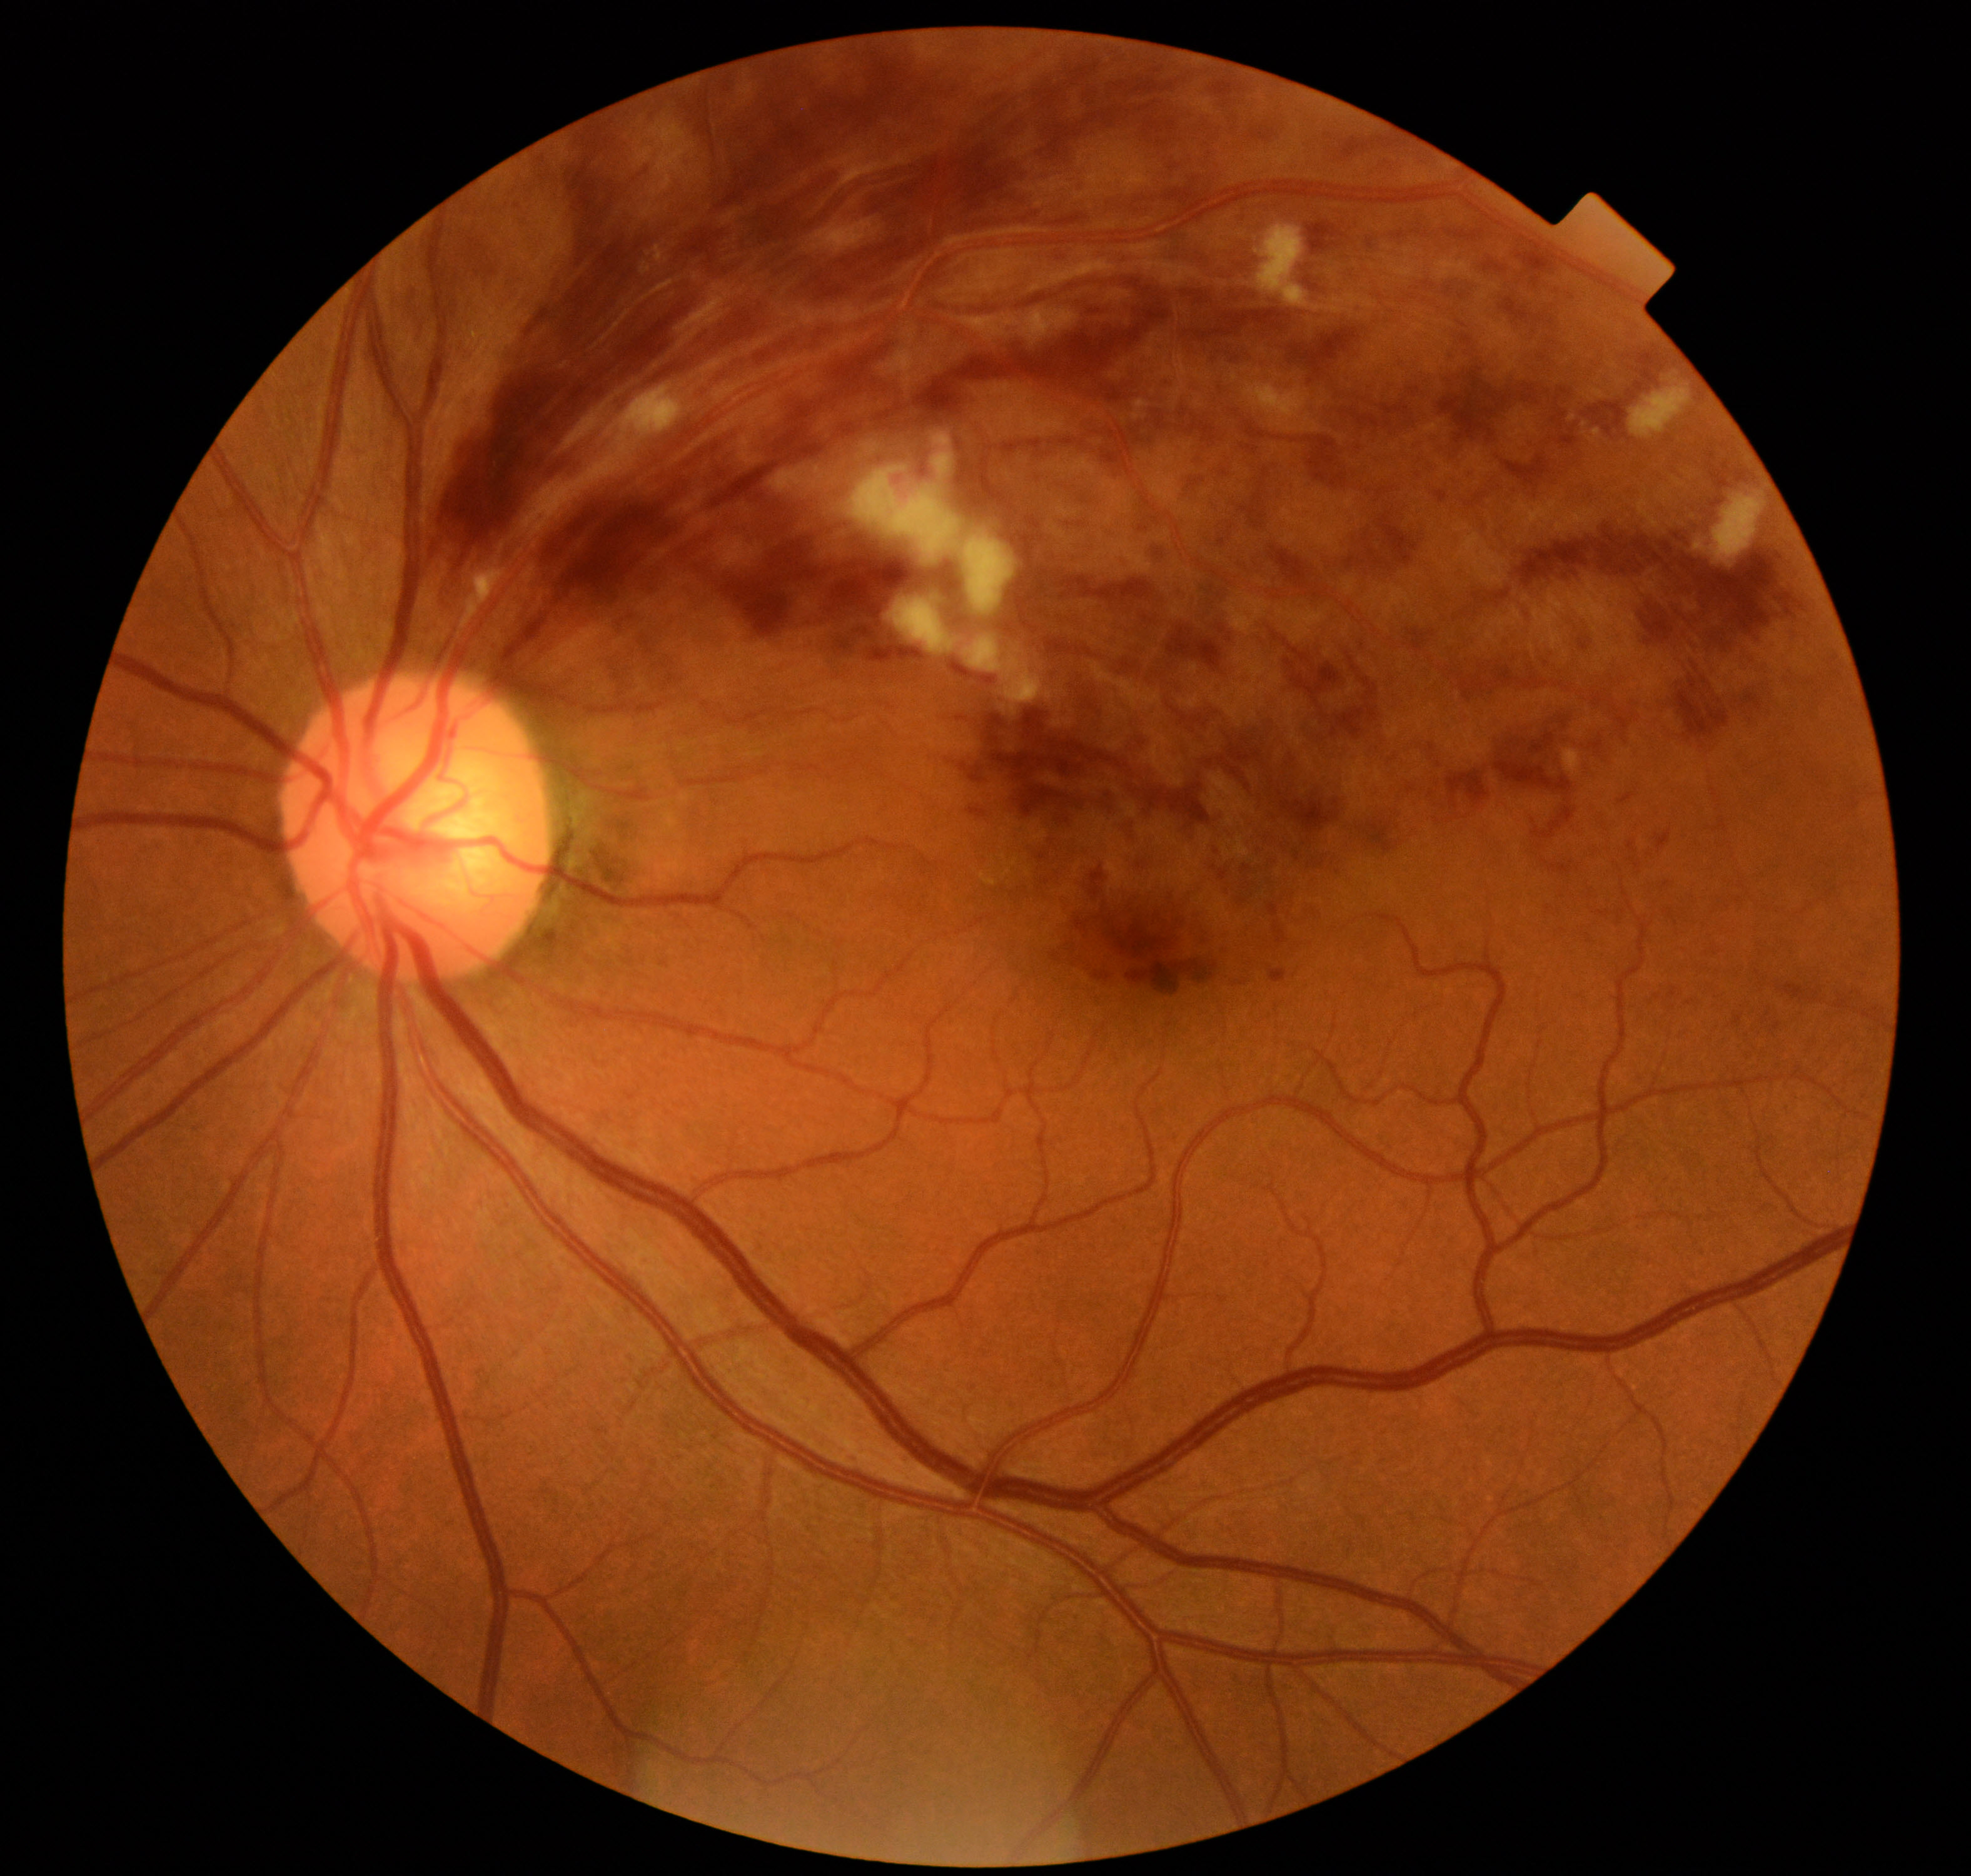
Diagnosis: branch retinal vein occlusion.